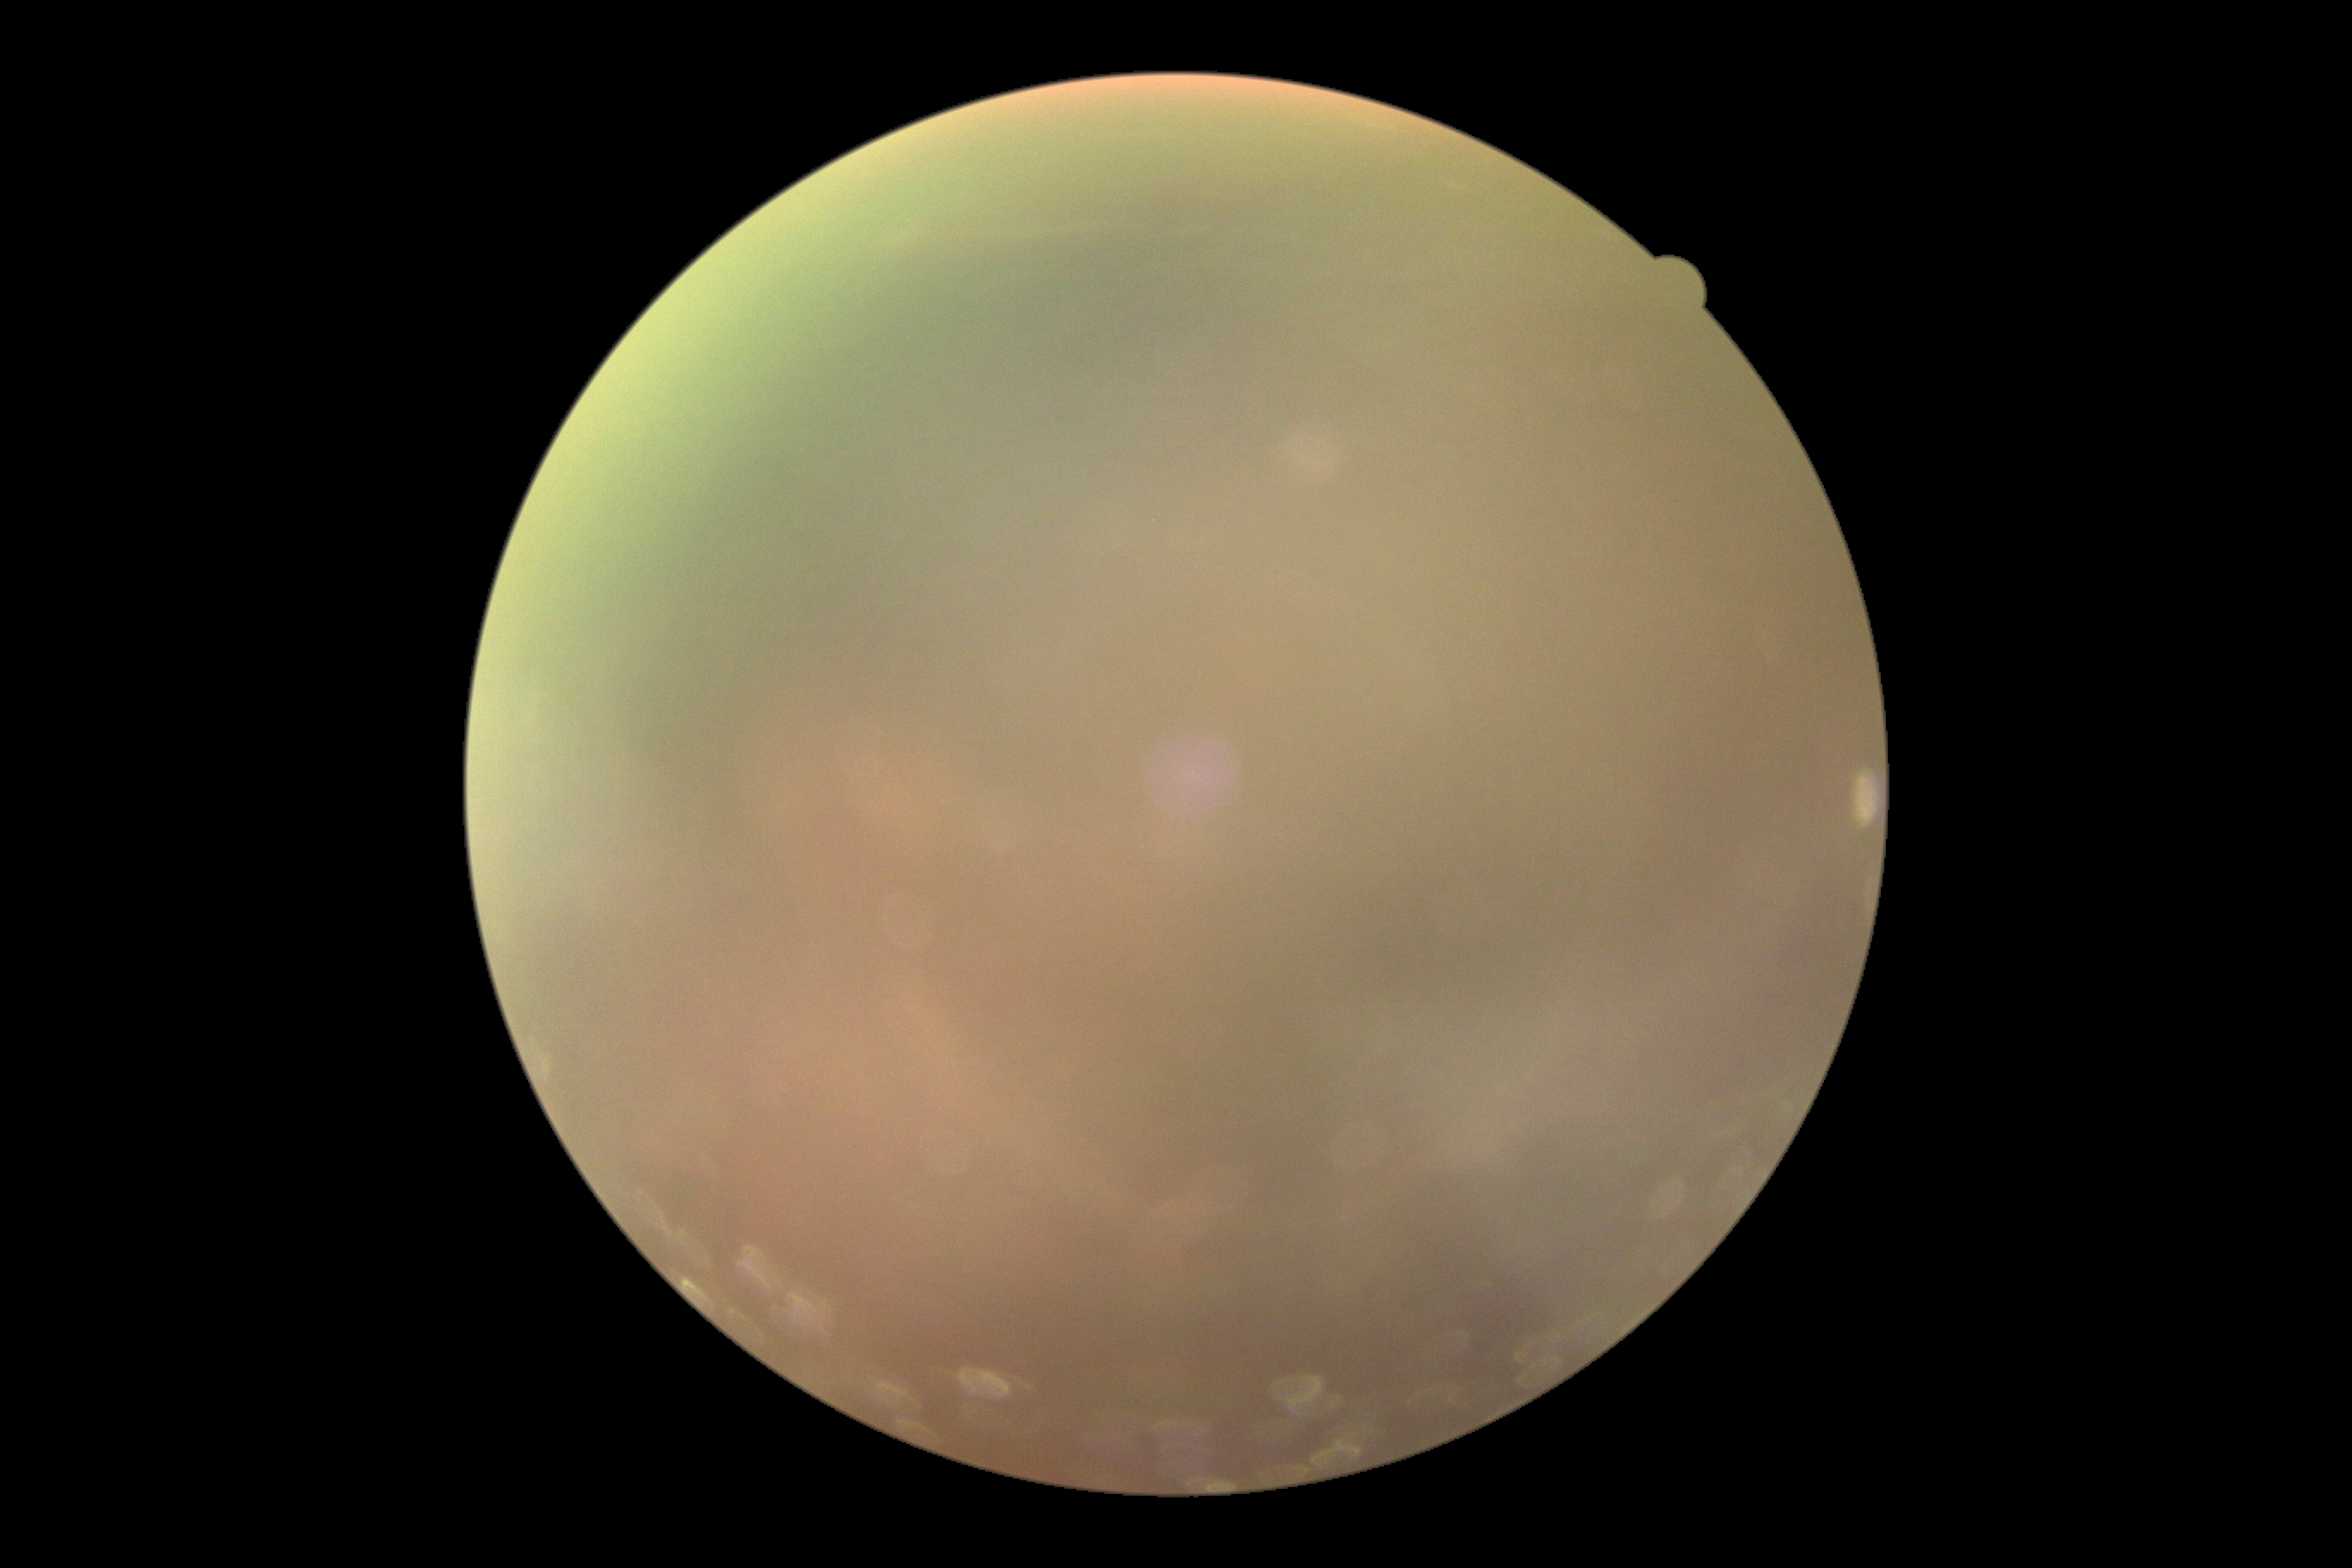
Retinopathy grade: ungradable due to poor image quality.